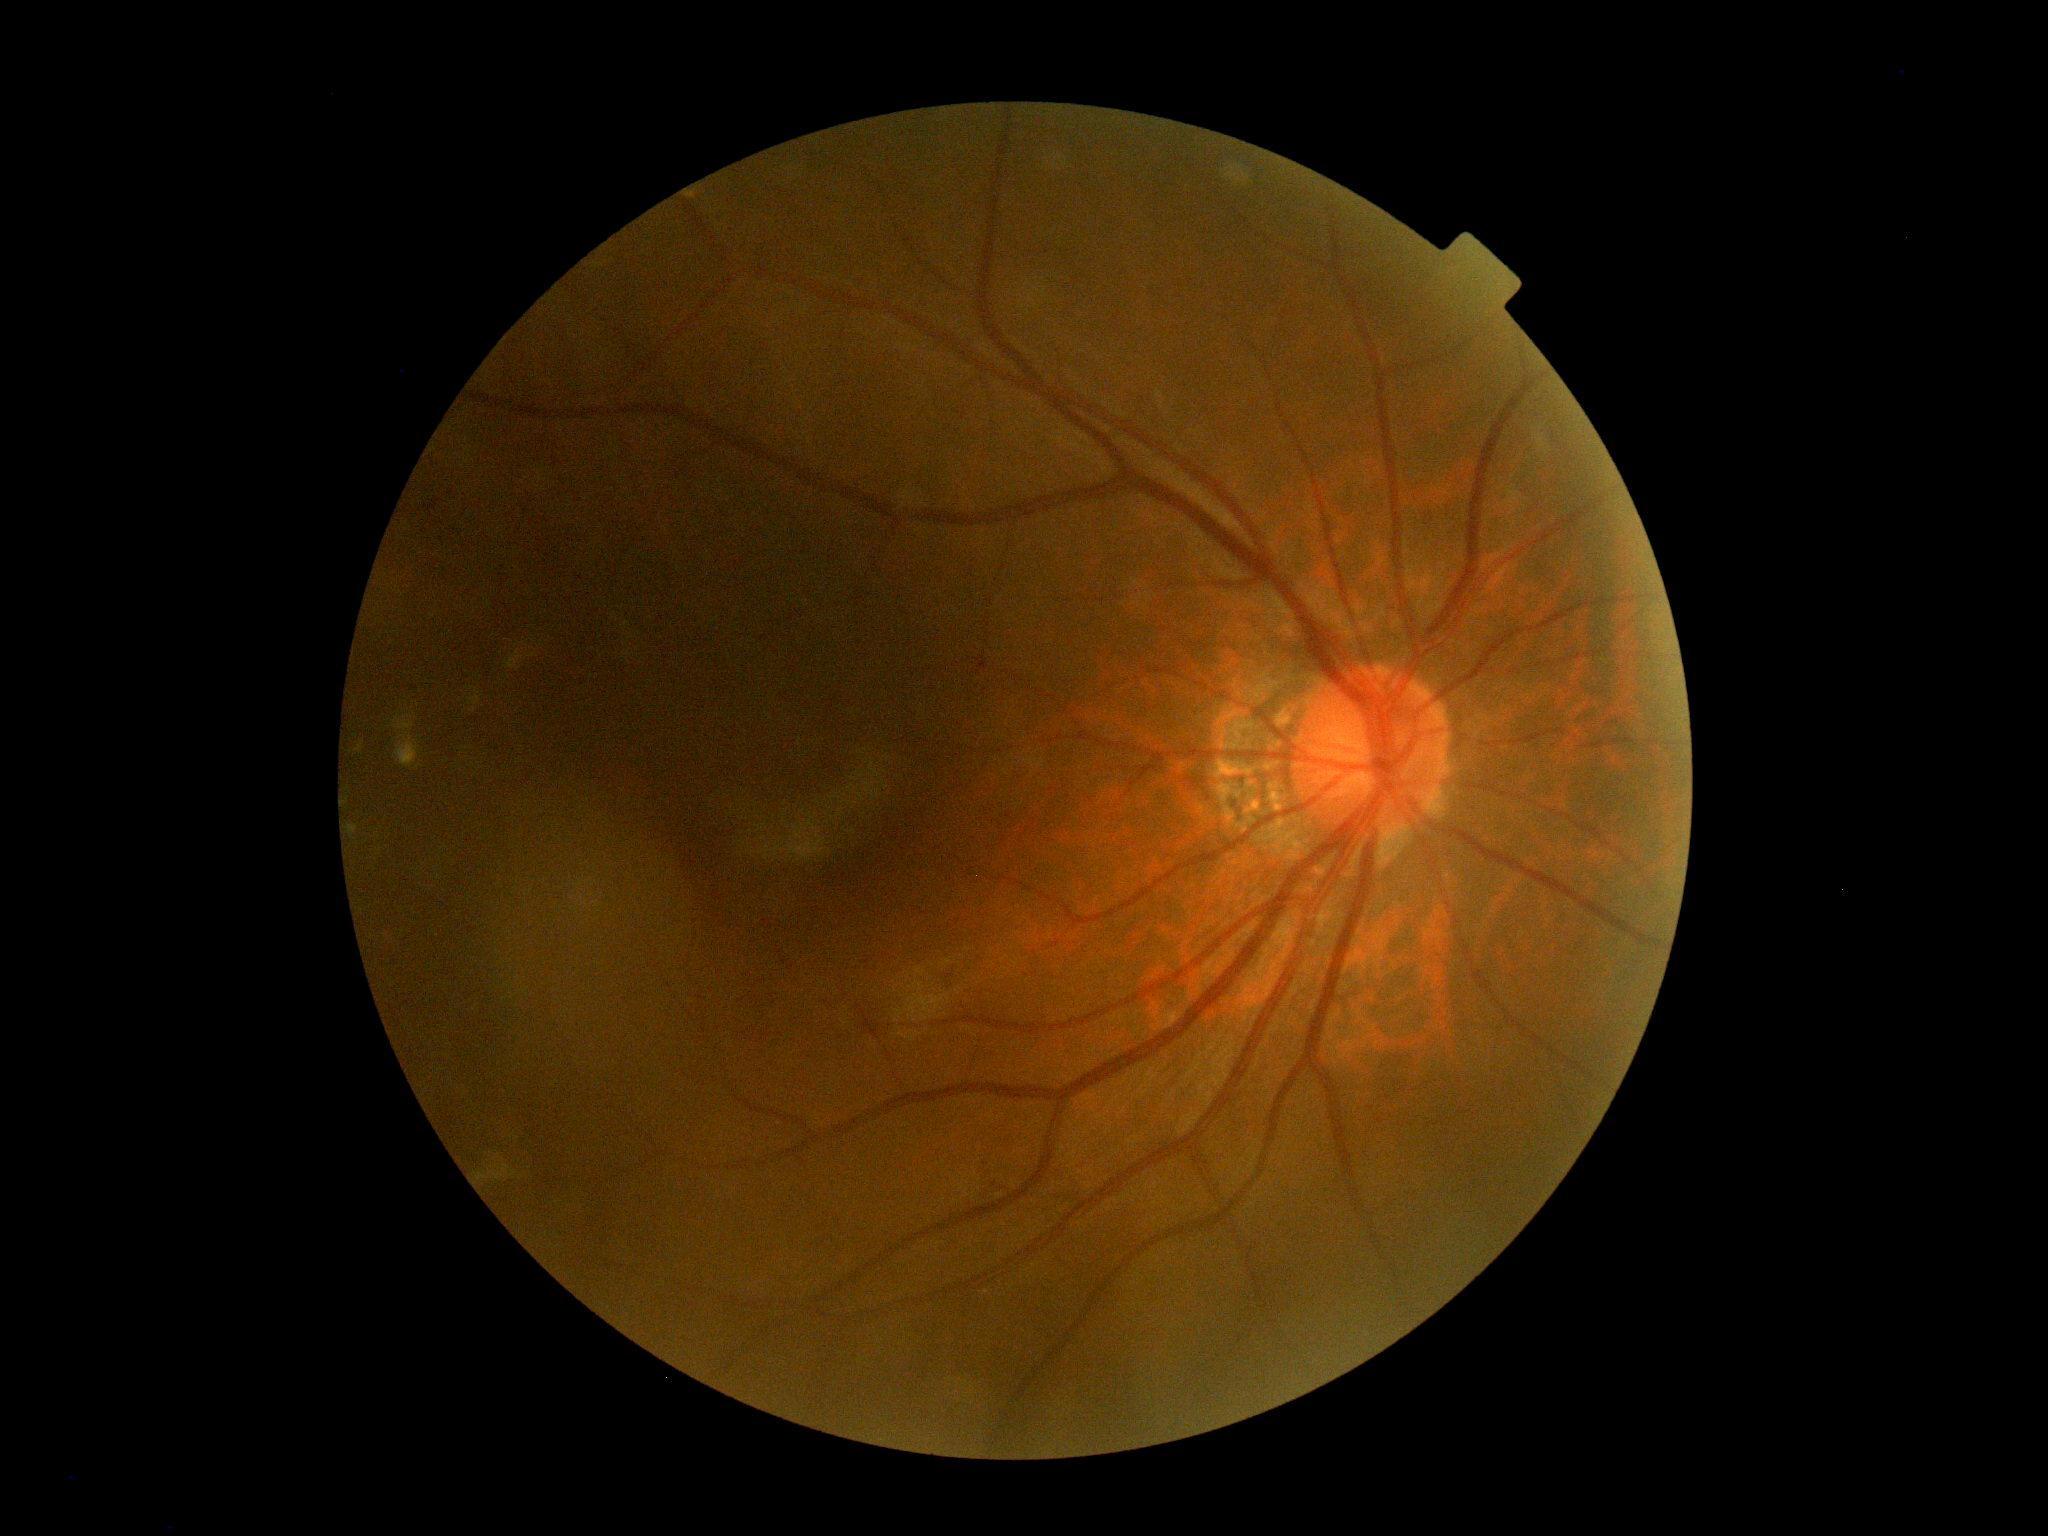
{"dr_impression": "no apparent DR", "dr_grade": "grade 0"}